Wide-field fundus photograph from neonatal ROP screening — 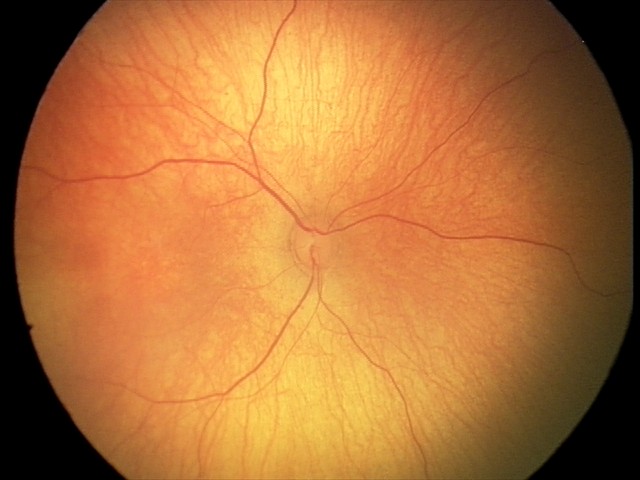 No retinal pathology identified on screening.